Camera: Phoenix ICON (100° FOV) · image size 1240x1240 · Phoenix ICON wide-field infant fundus image:
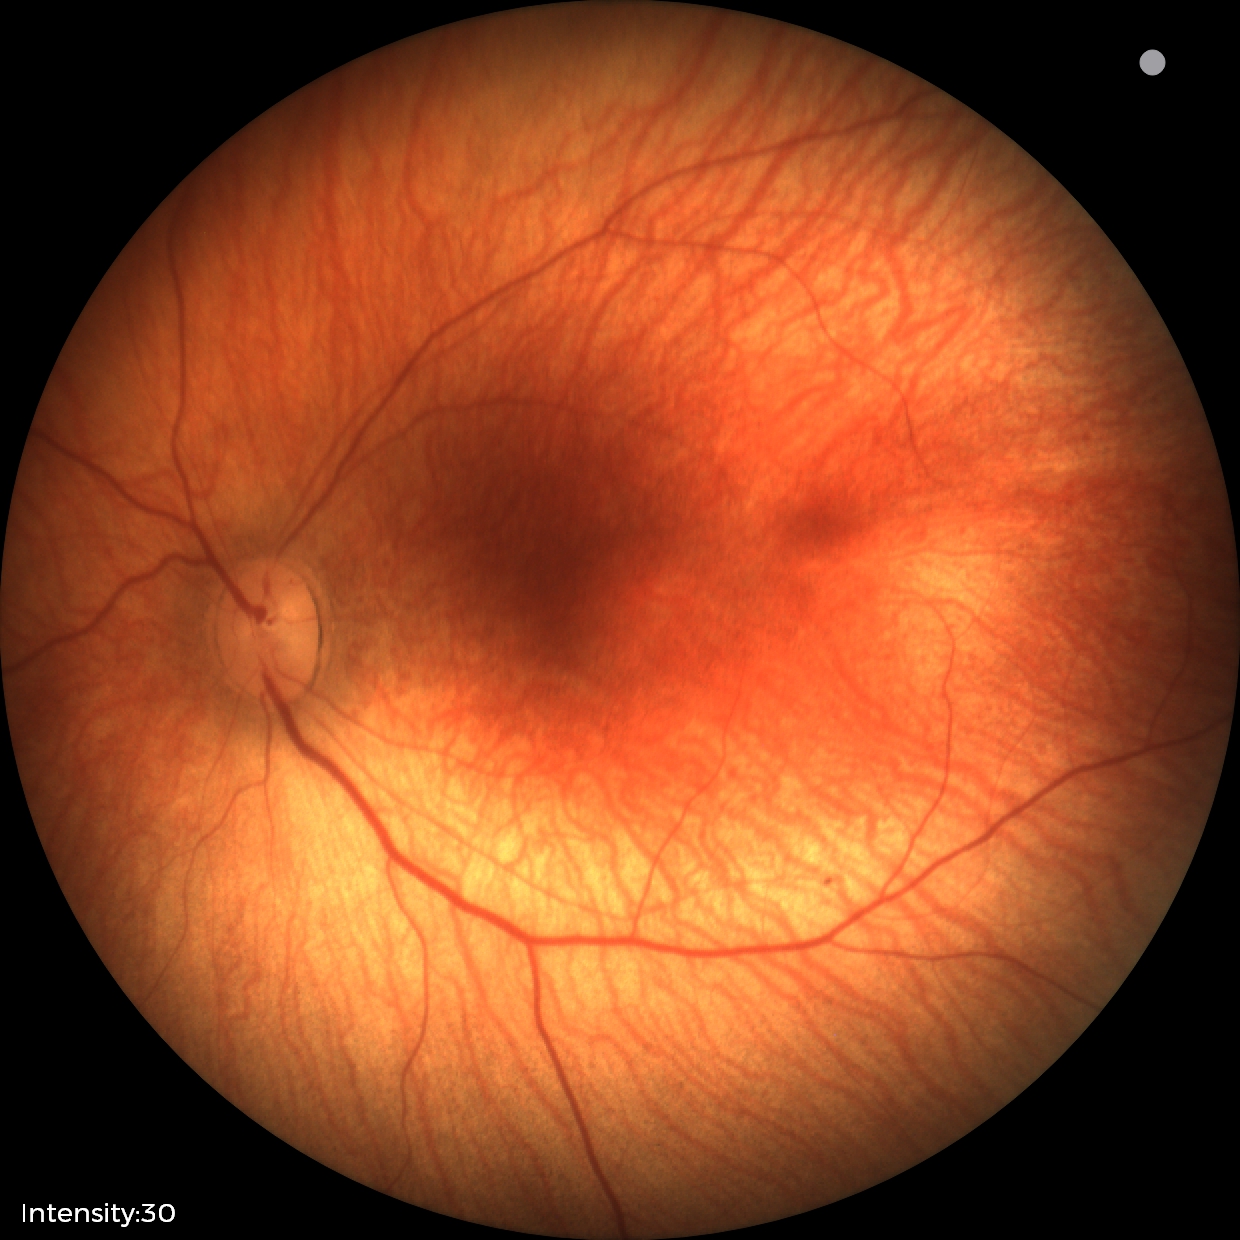 Physiological retinal appearance for postconceptual age.